Natus RetCam Envision, 130° FOV · wide-field fundus photograph of an infant · 1440x1080 — 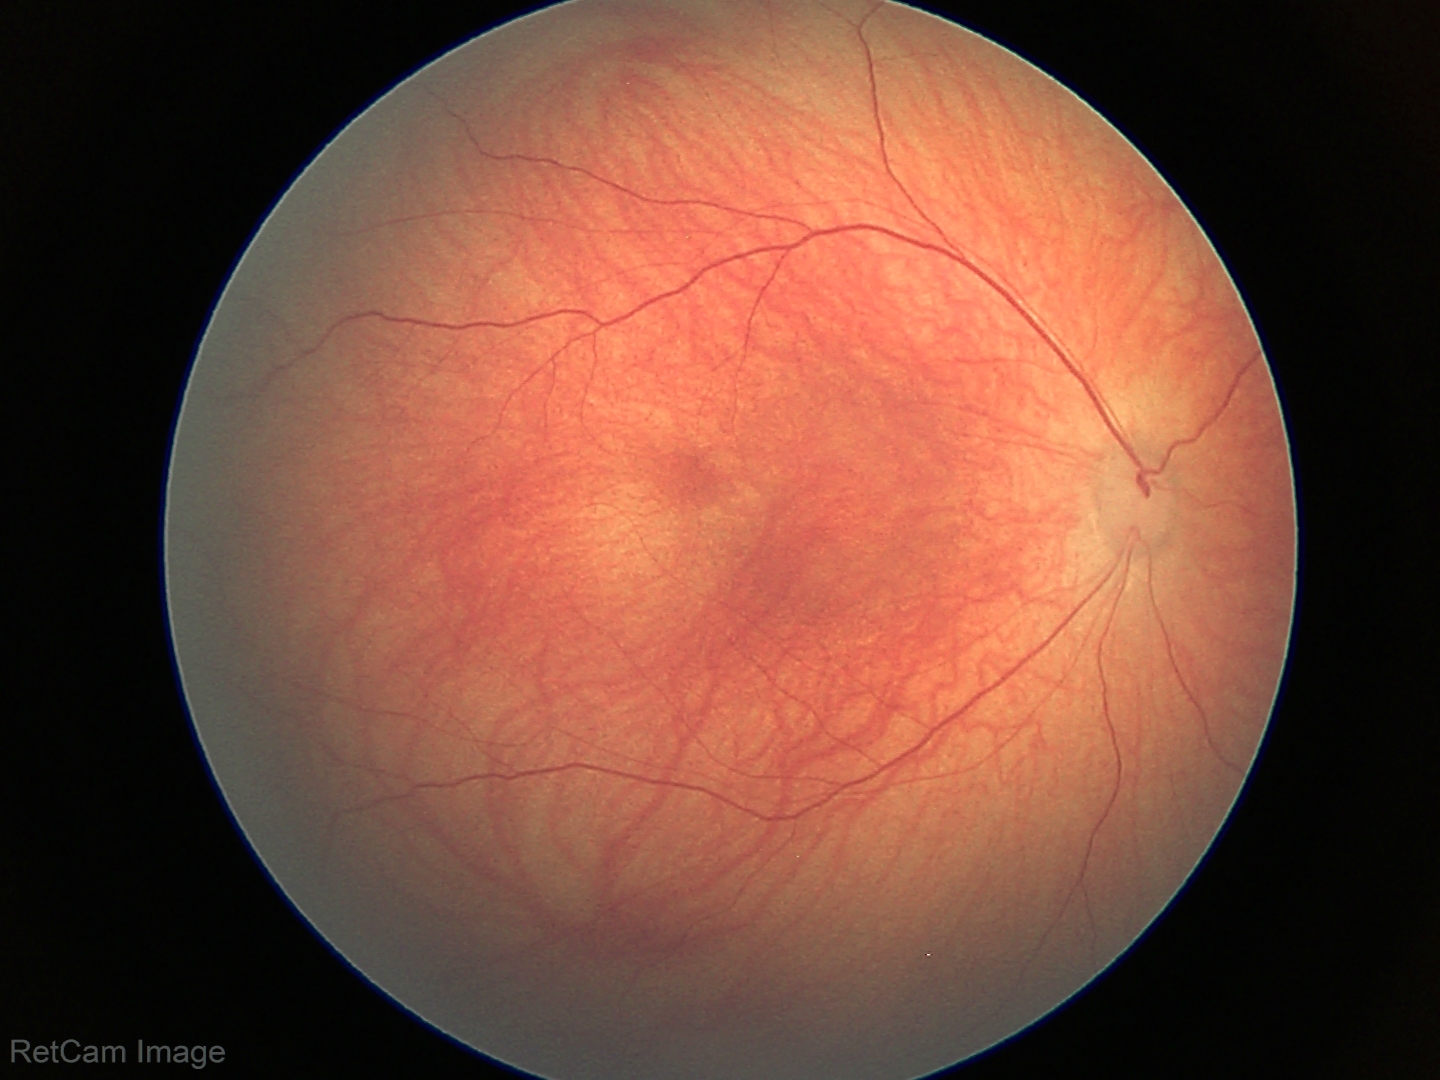
Examination with physiological retinal findings.